Without pupil dilation, modified Davis classification: 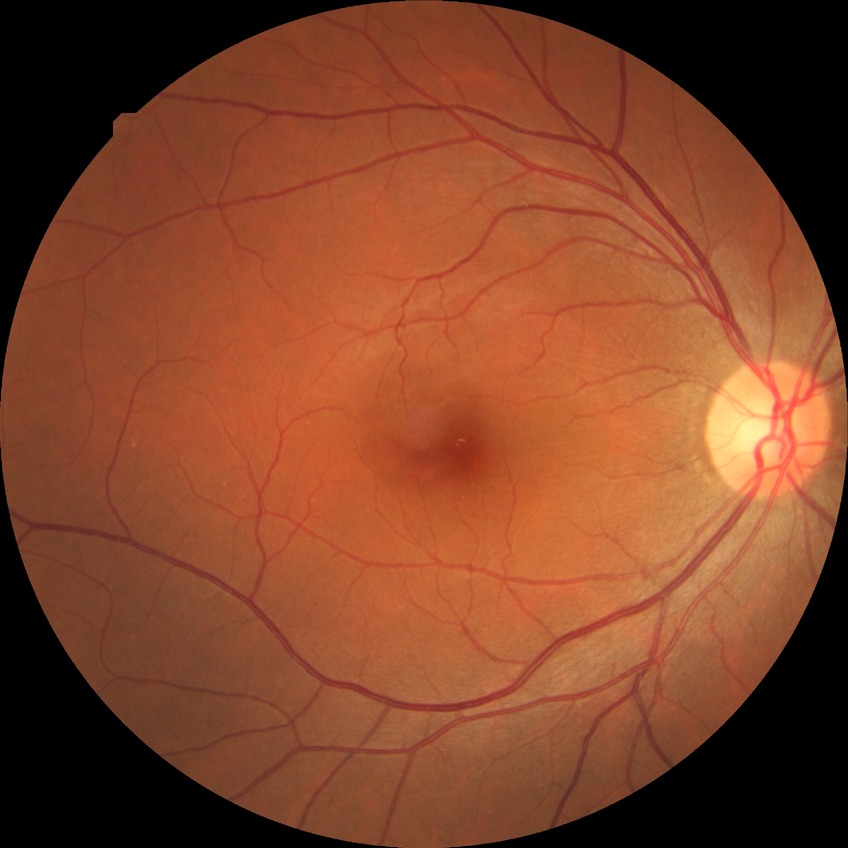 Diabetic retinopathy grade is no diabetic retinopathy.